2352x1568, 45° FOV — 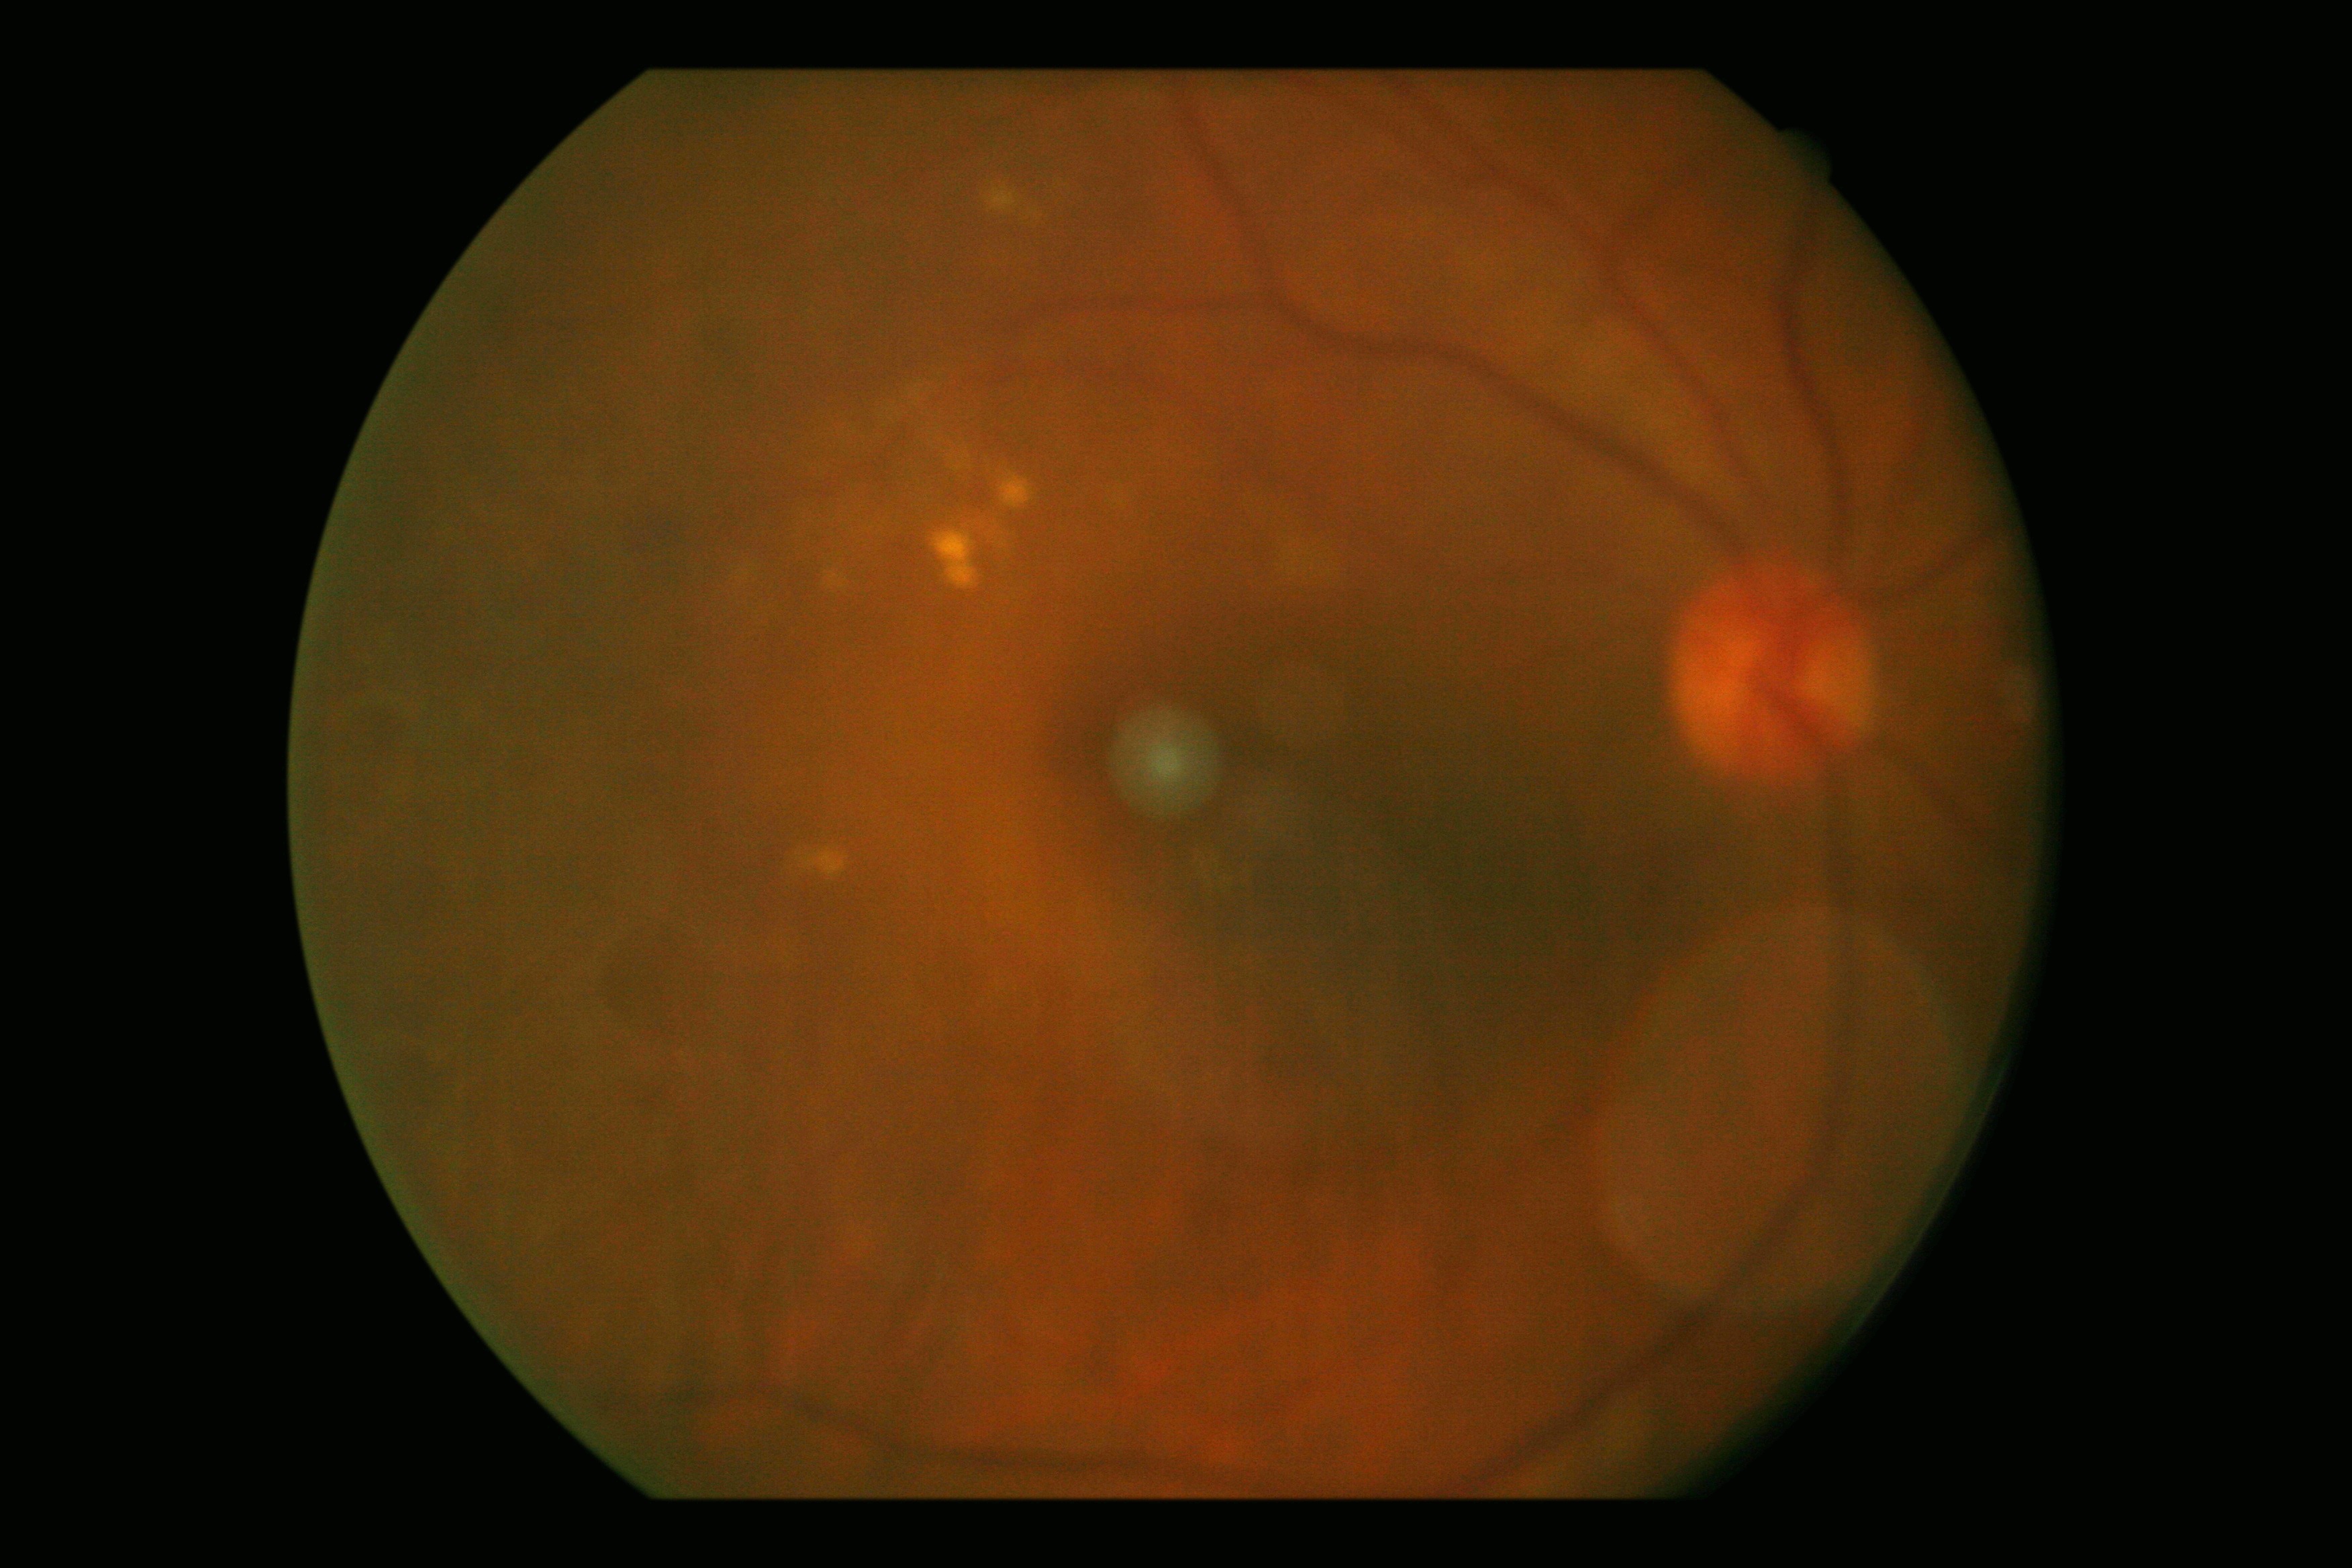
DR grade = 2.